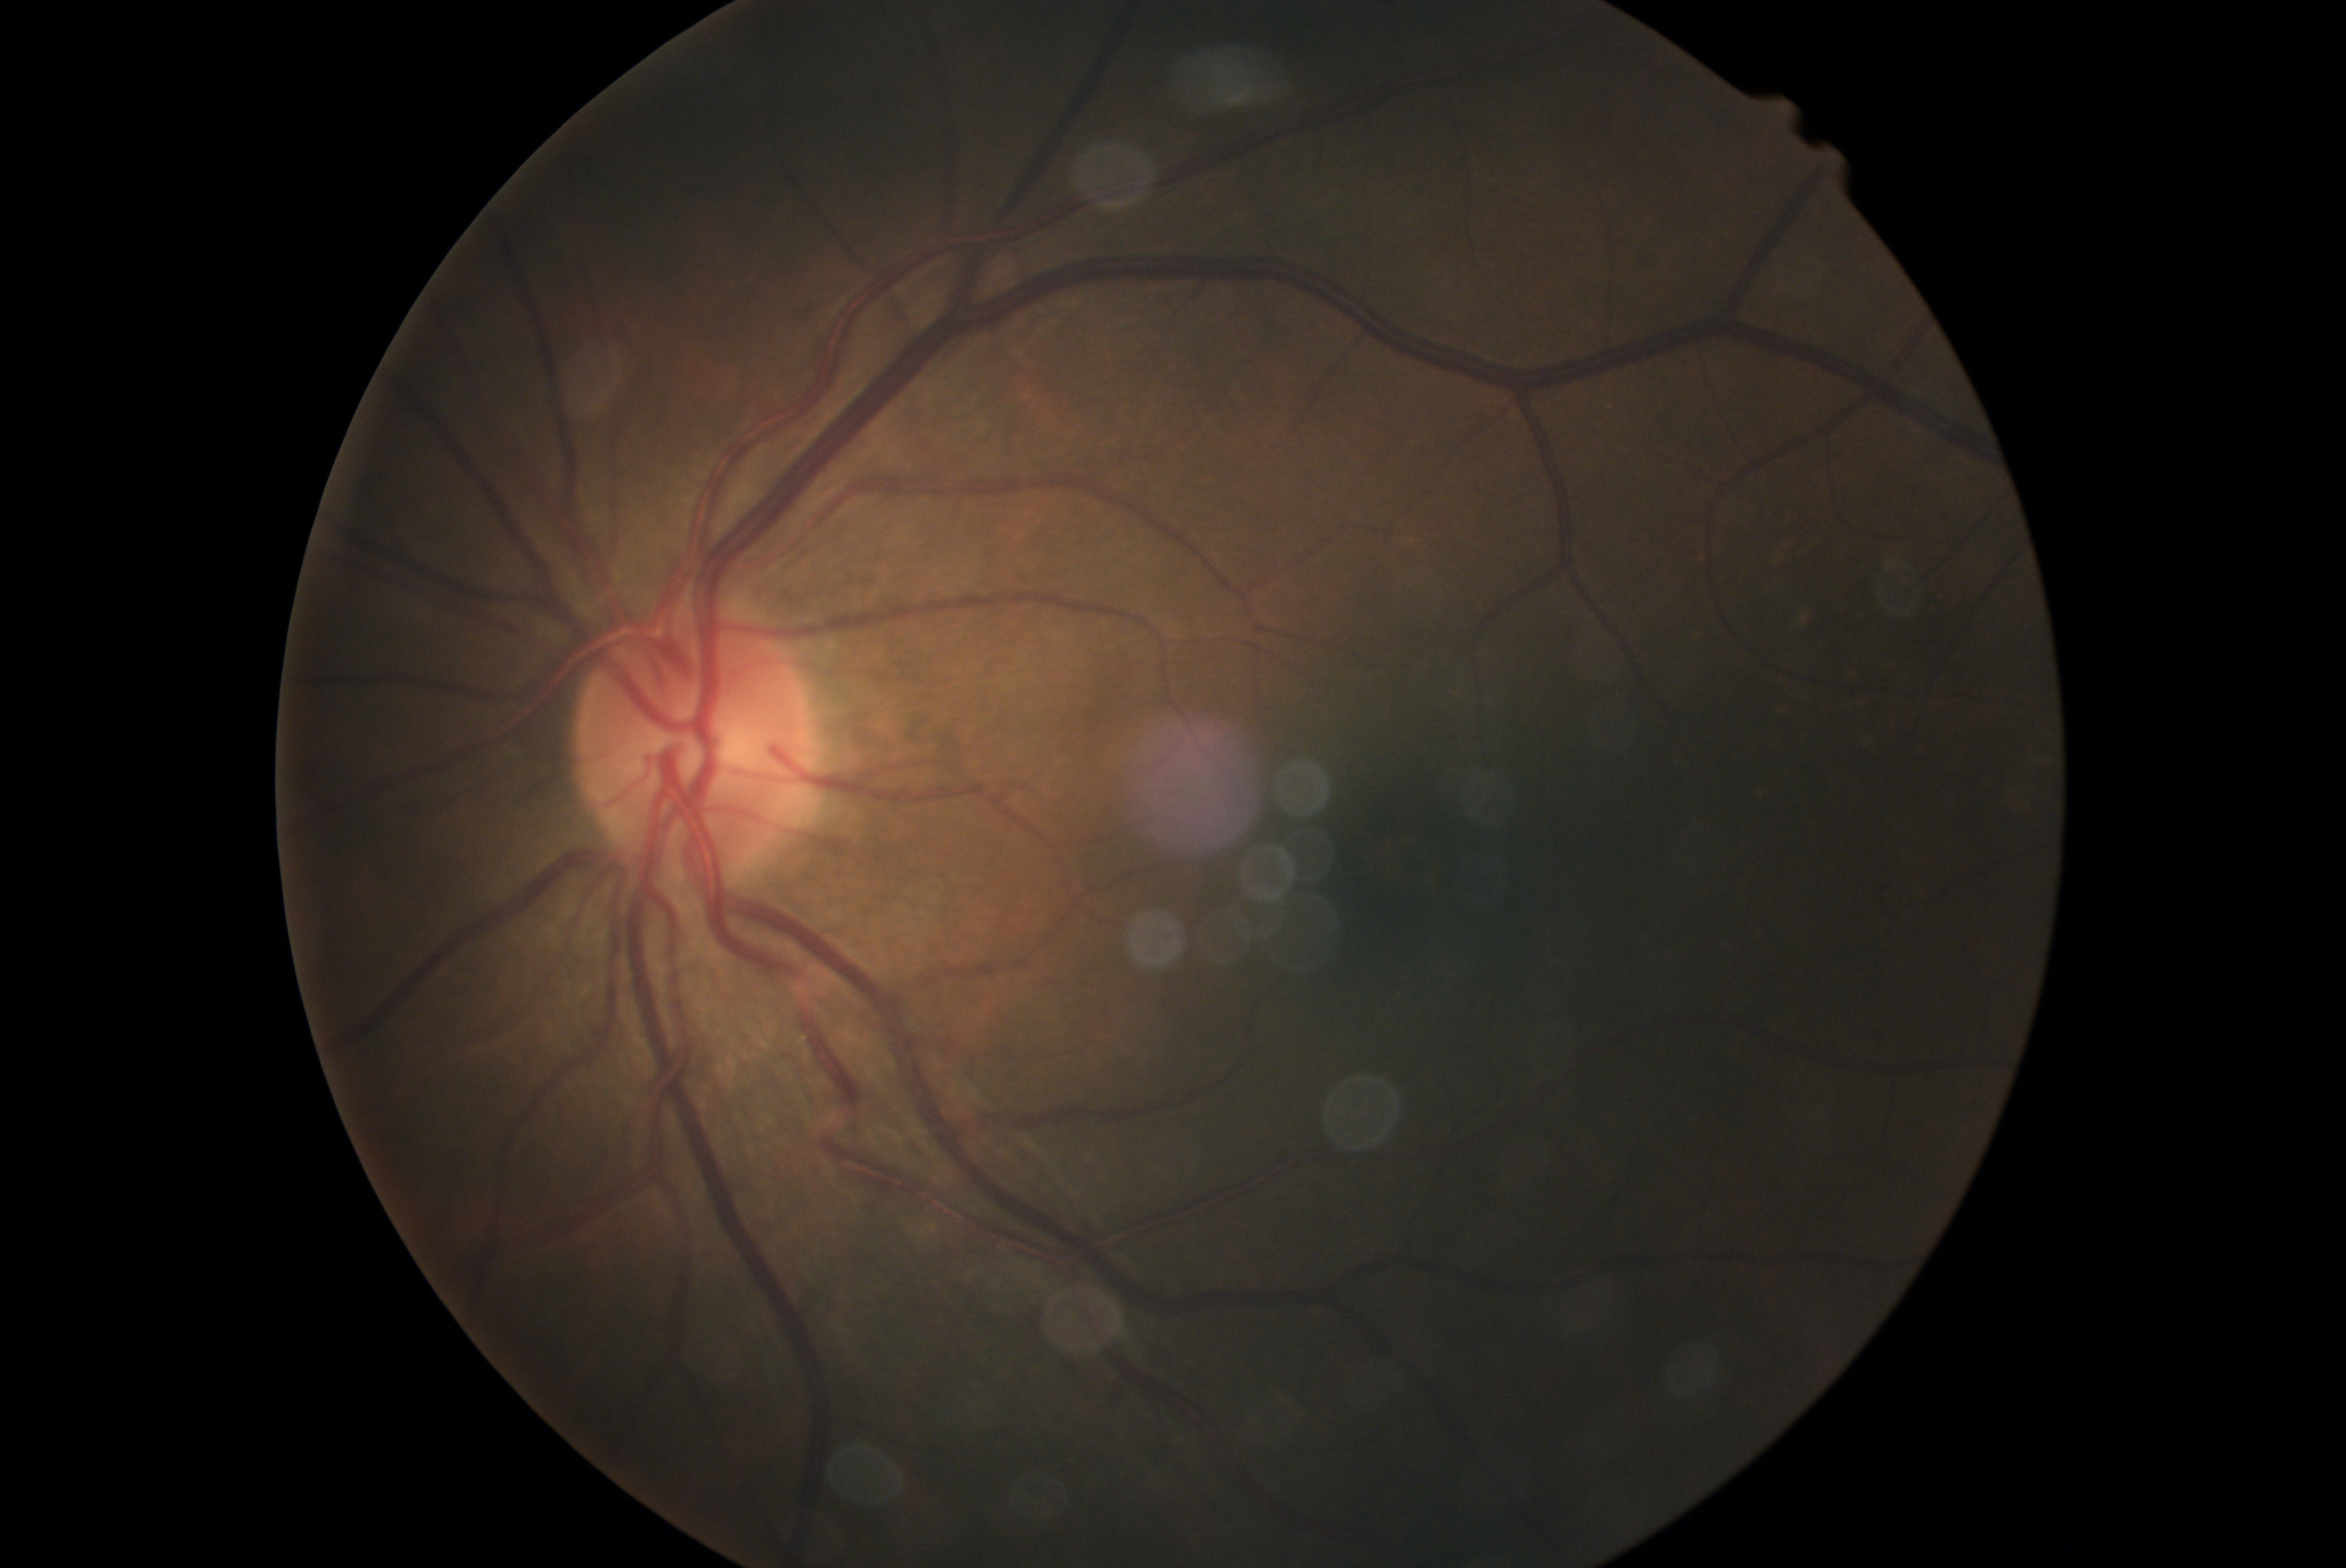
Diabetic retinopathy grade: 0 — no visible signs of diabetic retinopathy.